Non-mydriatic, cropped to the optic nerve head:
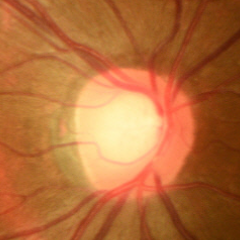

Showing no glaucomatous optic neuropathy.